Phoenix ICON wide-field infant fundus image.
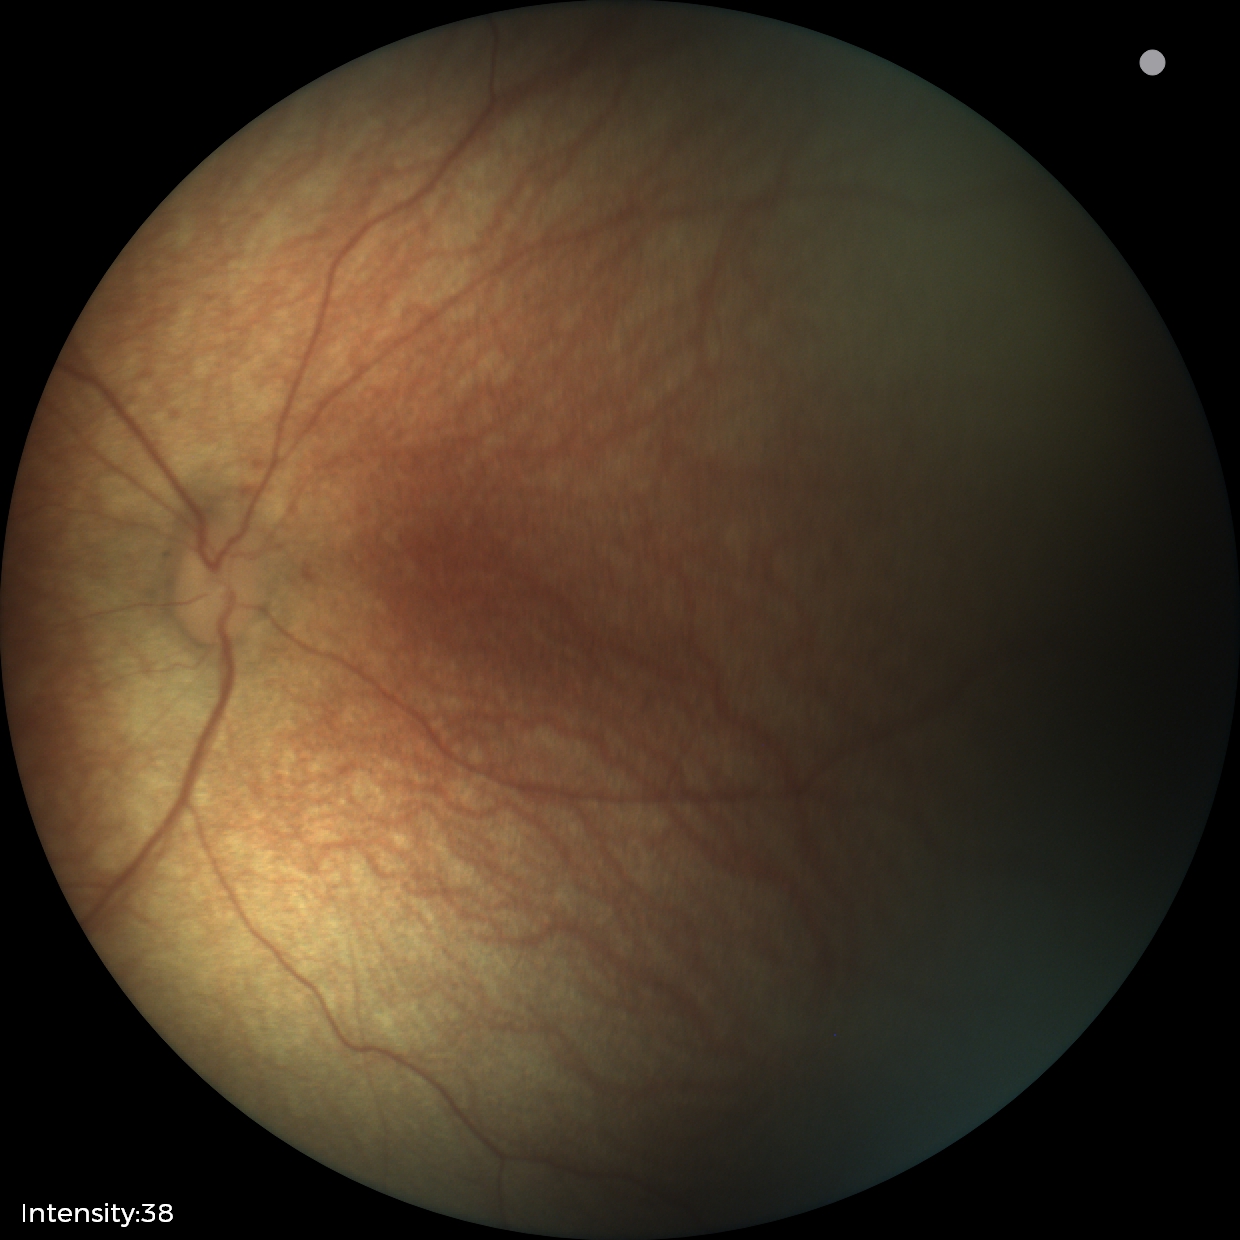 Impression = no abnormalities.